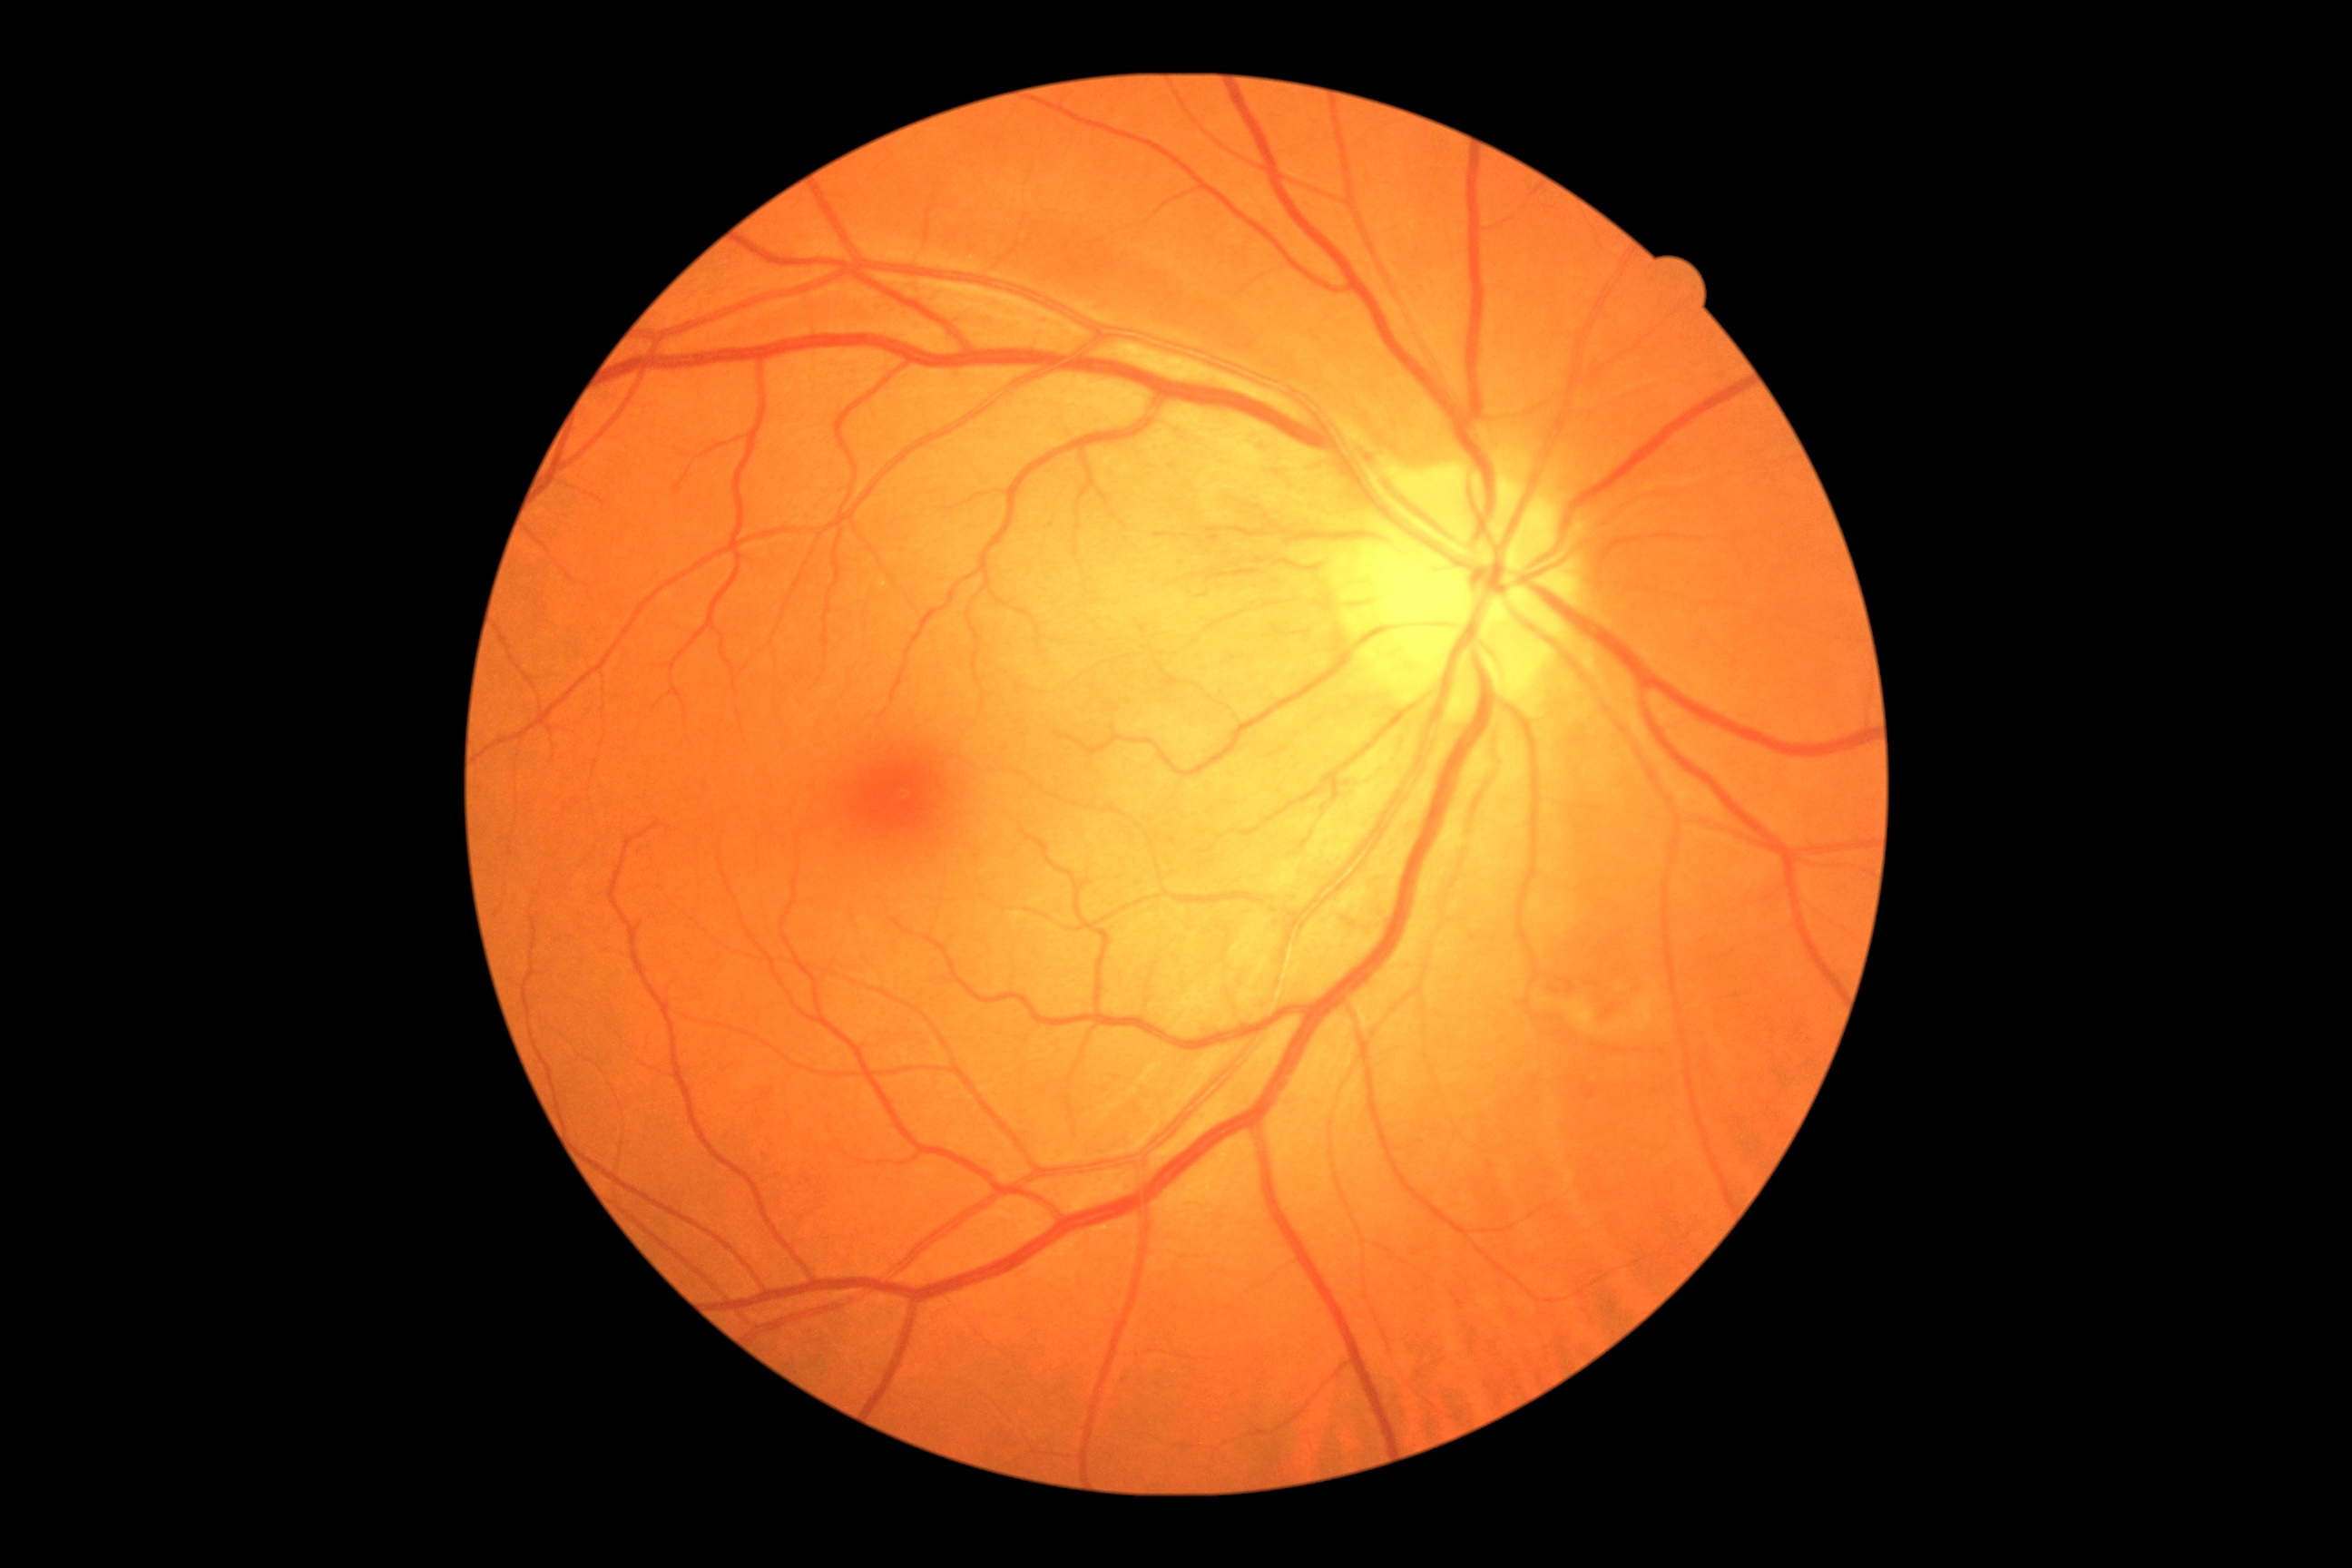 diabetic retinopathy severity: 2/4.